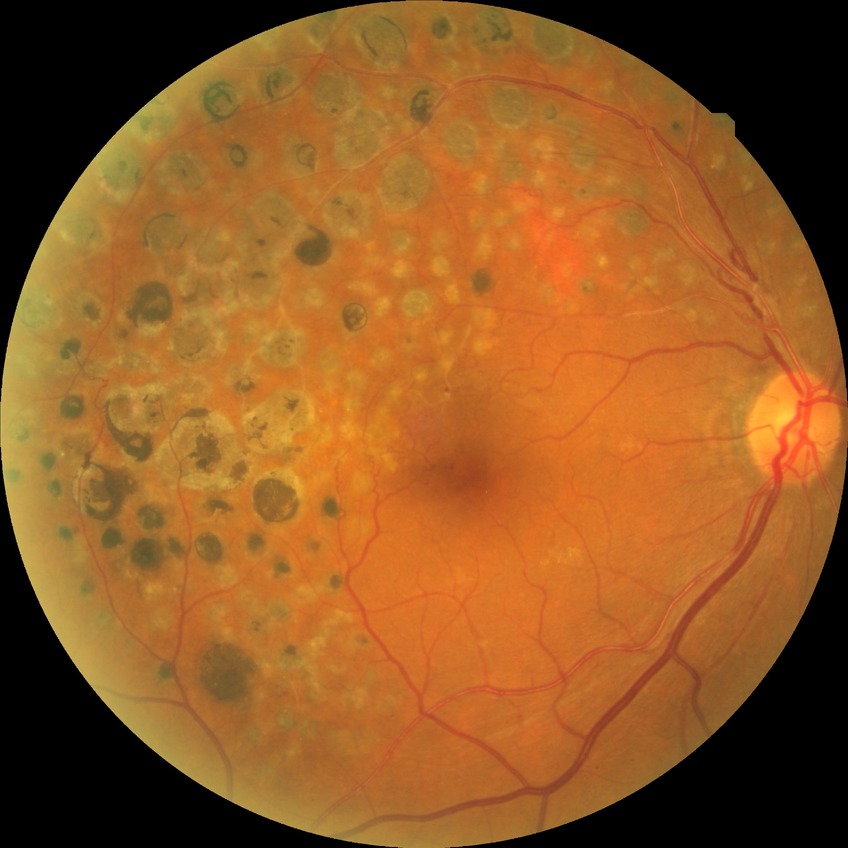 Diabetic retinopathy severity is no diabetic retinopathy.